Fundus photo, no pharmacologic dilation — 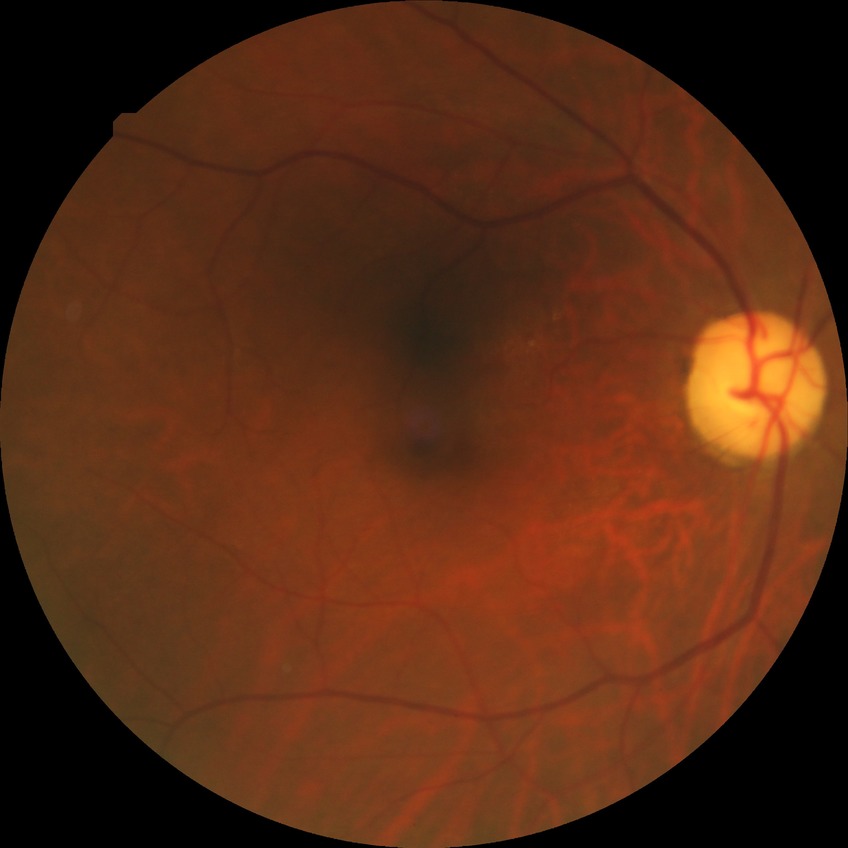

Assessment:
– Davis grade — NDR